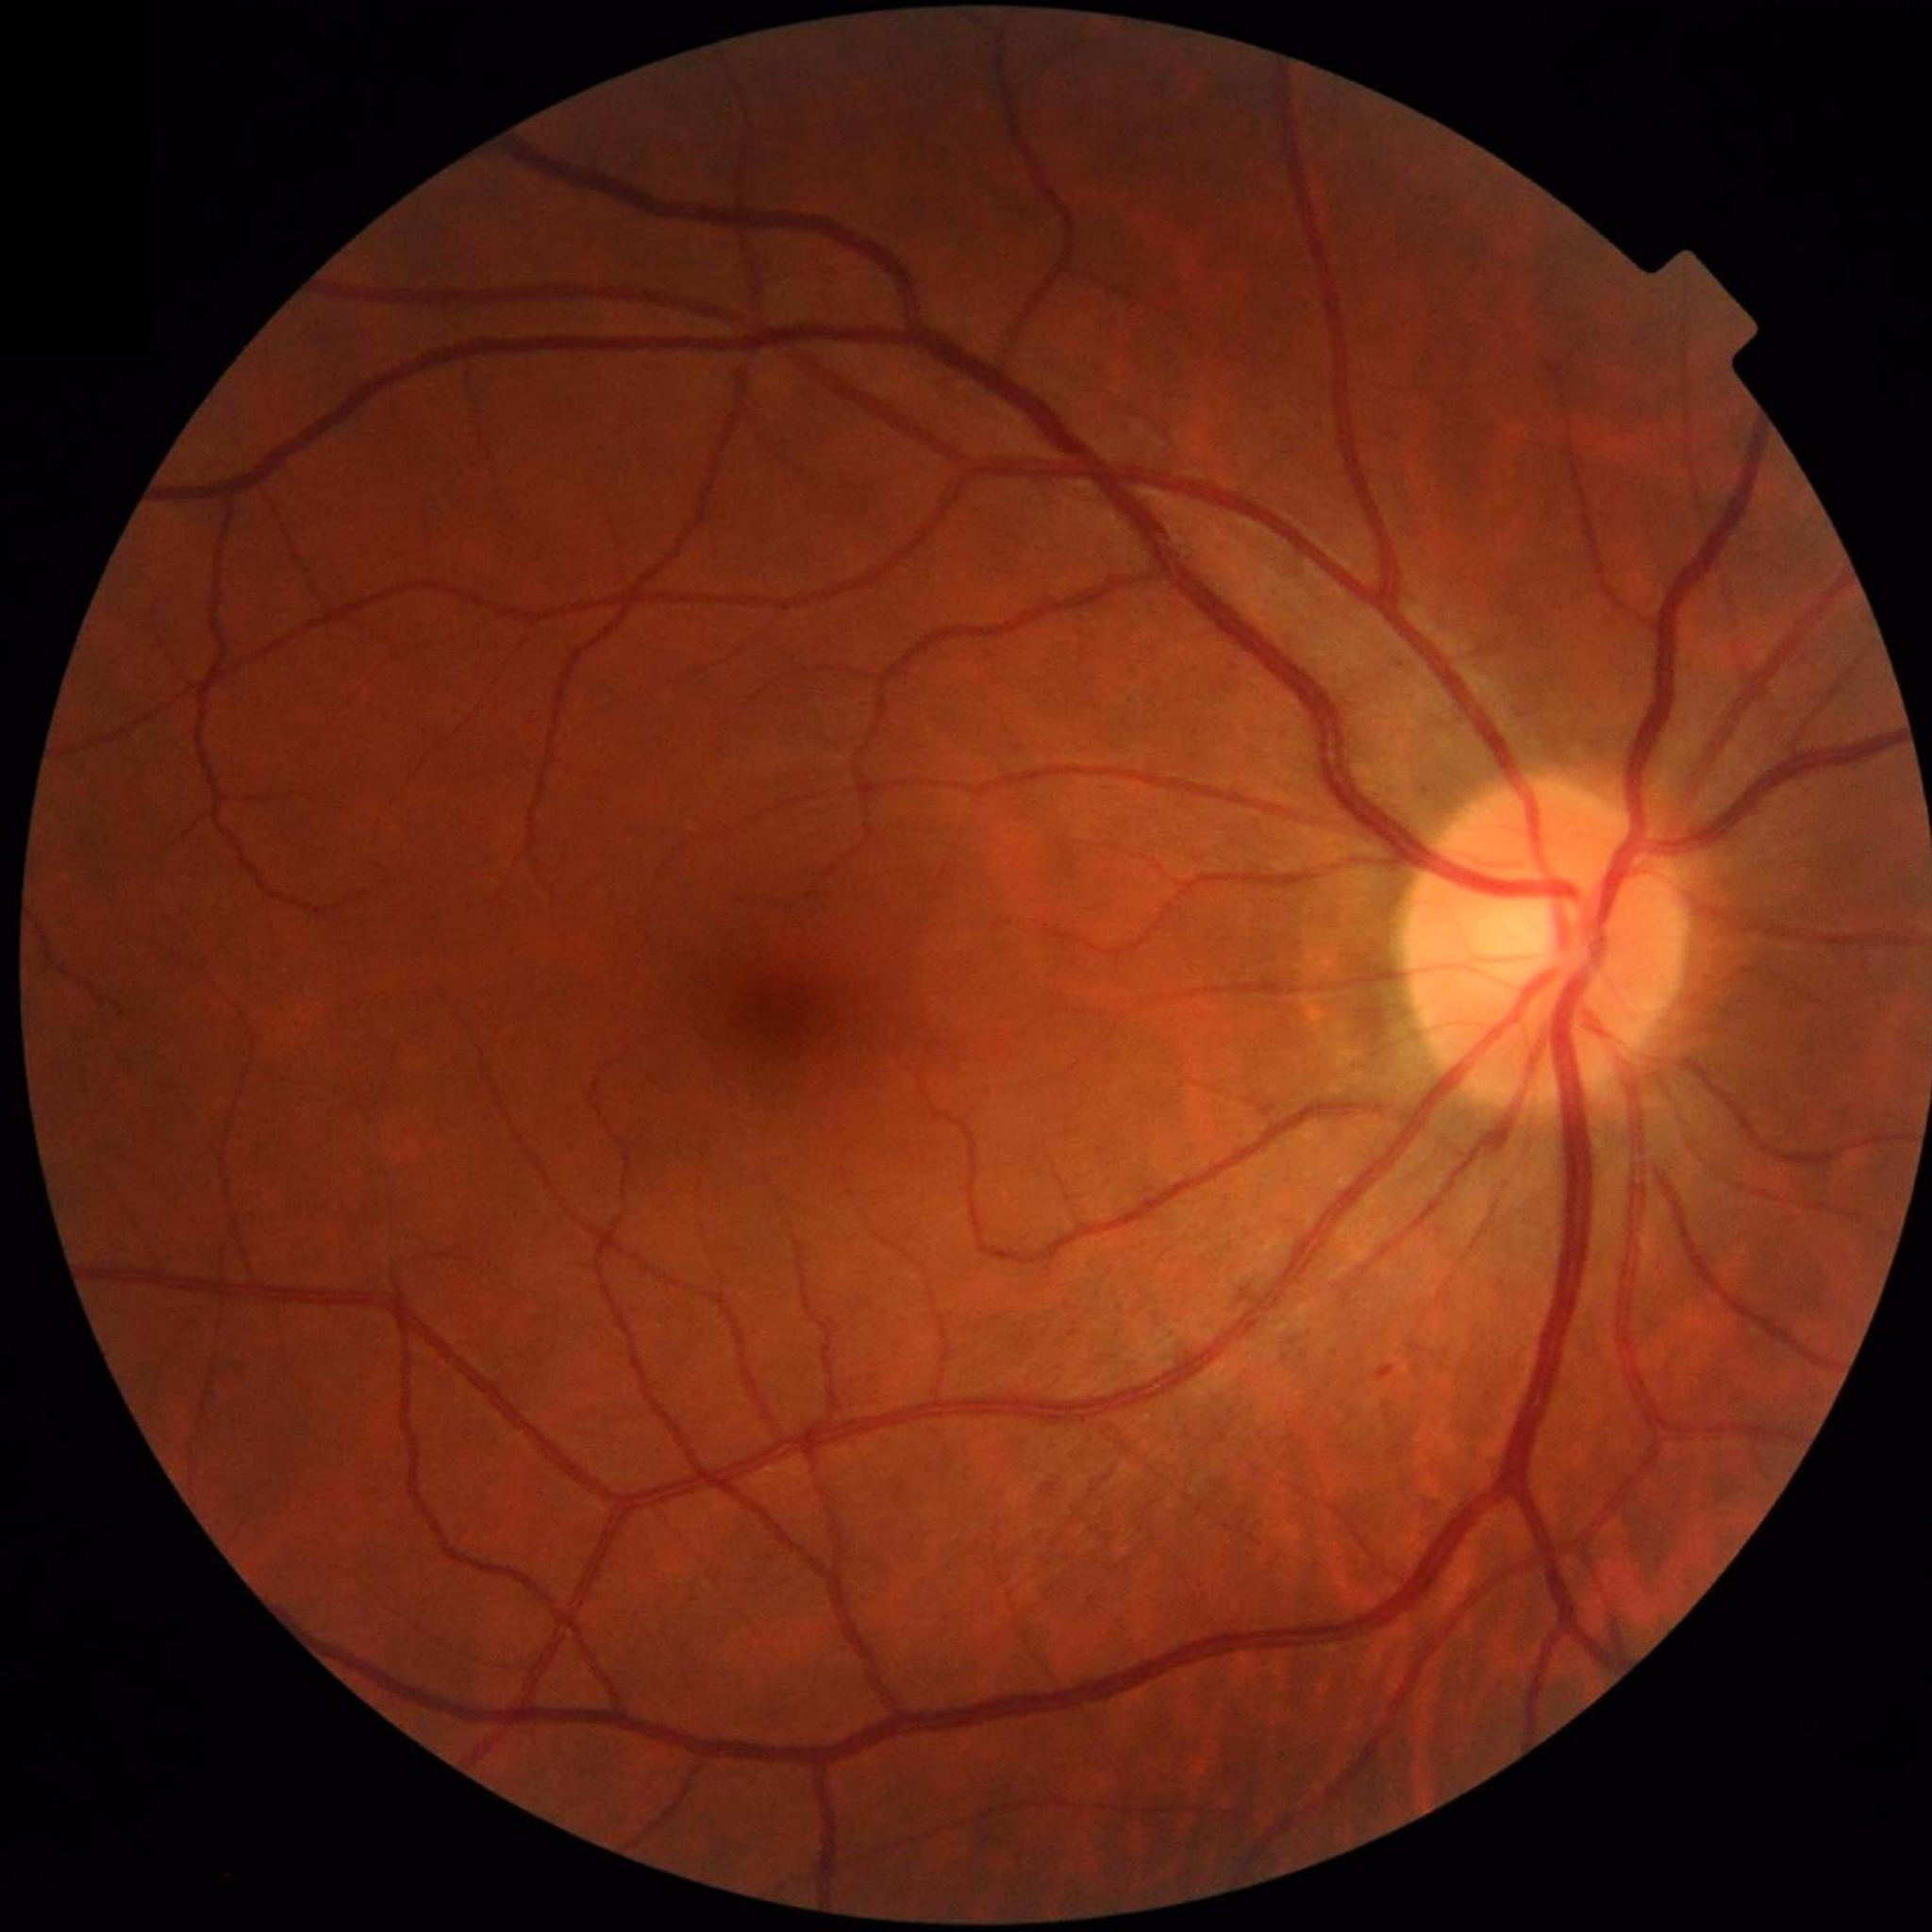
Photo quality: satisfactory.
Color fundus photo from a control patient without diagnosed retinal disease.